Natus RetCam Envision, 130° FOV · wide-field fundus image from infant ROP screening
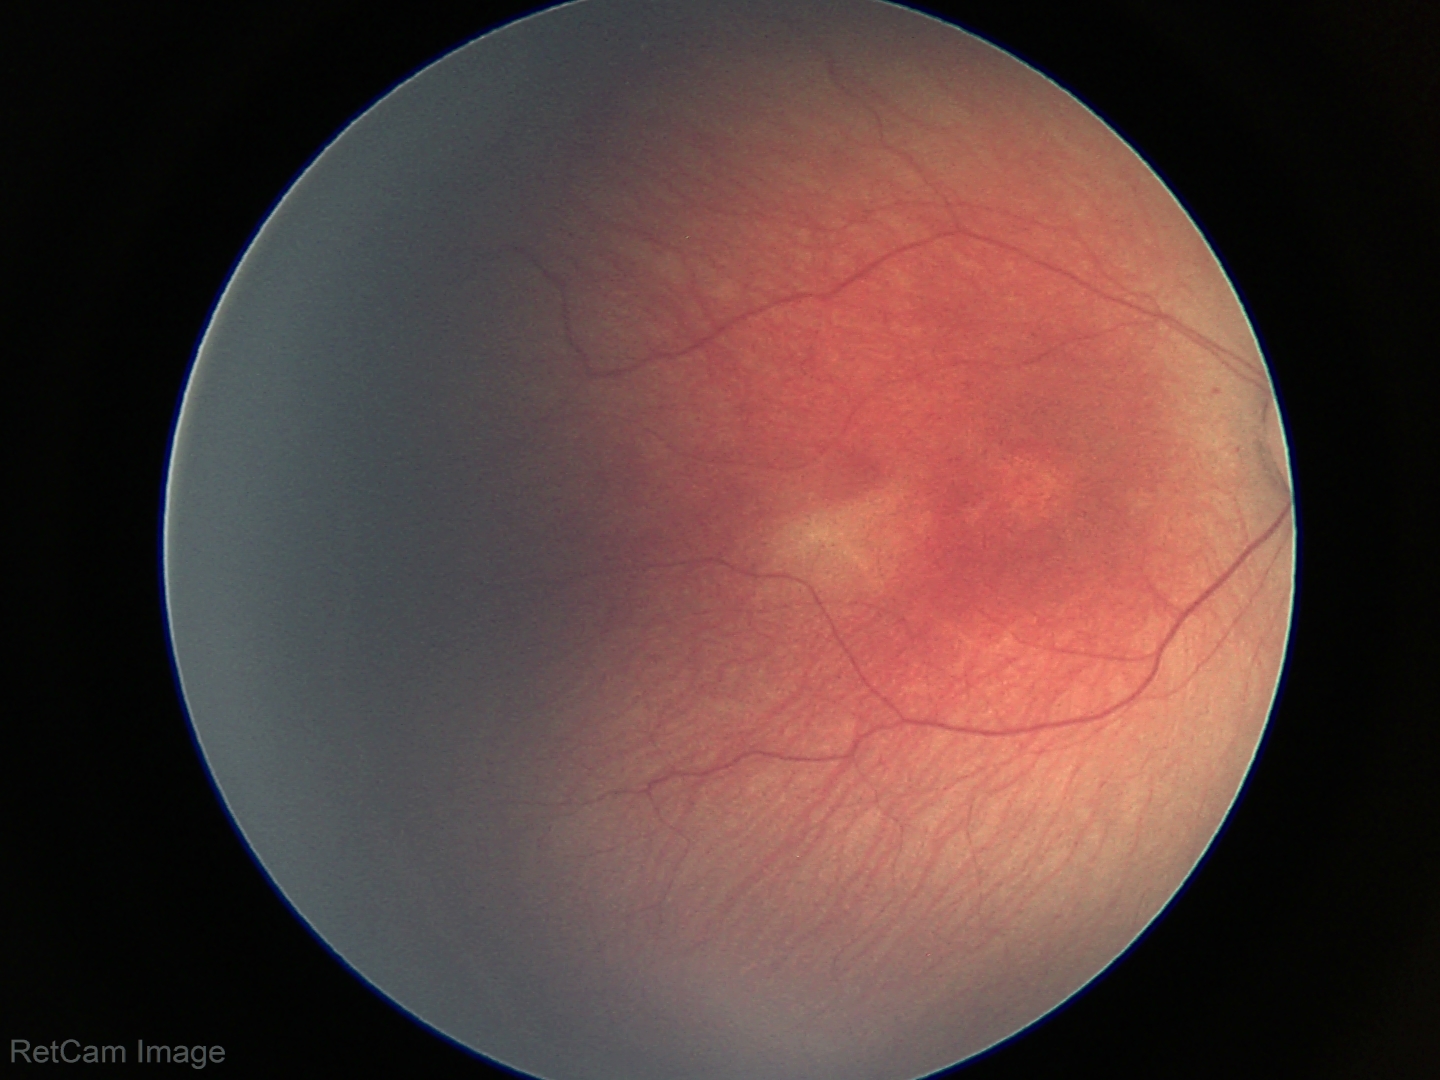 Screening series with retinopathy of prematurity stage 2.